Davis DR grading; 45° field of view; no pharmacologic dilation; 848x848; fundus photo.
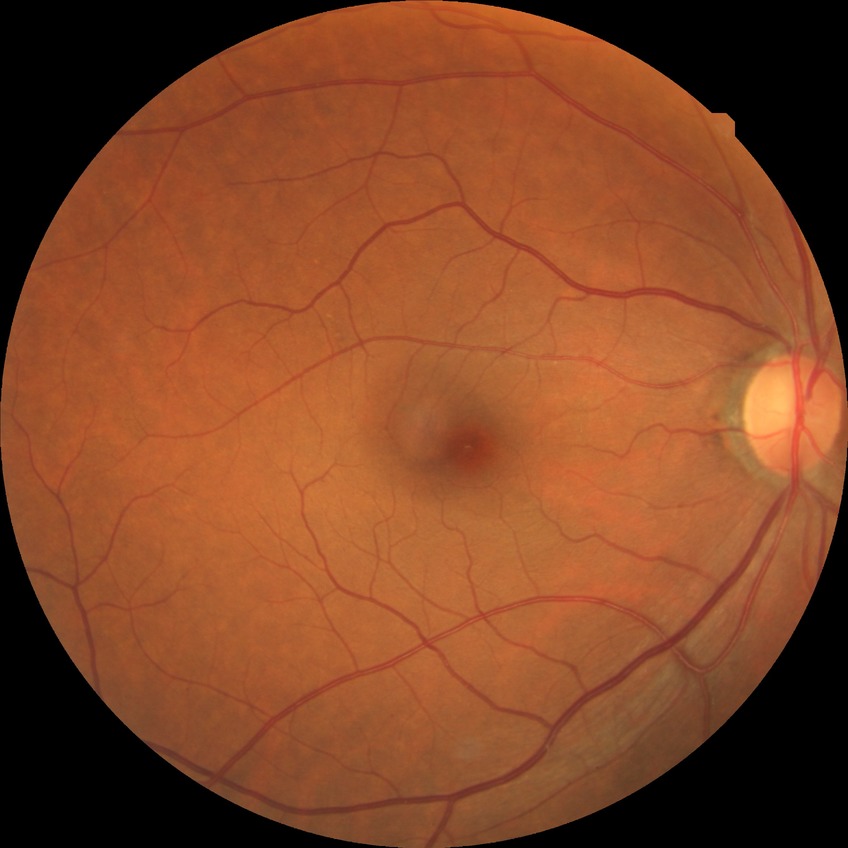 Diabetic retinopathy (DR): no diabetic retinopathy (NDR).